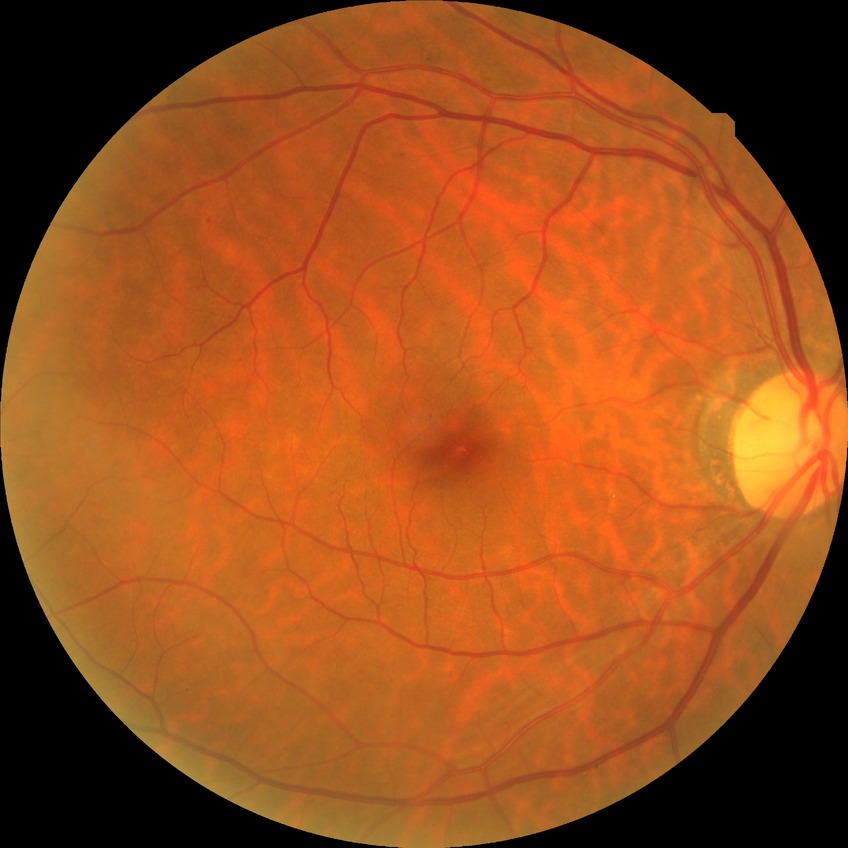 Davis stage: NDR. No DR findings.